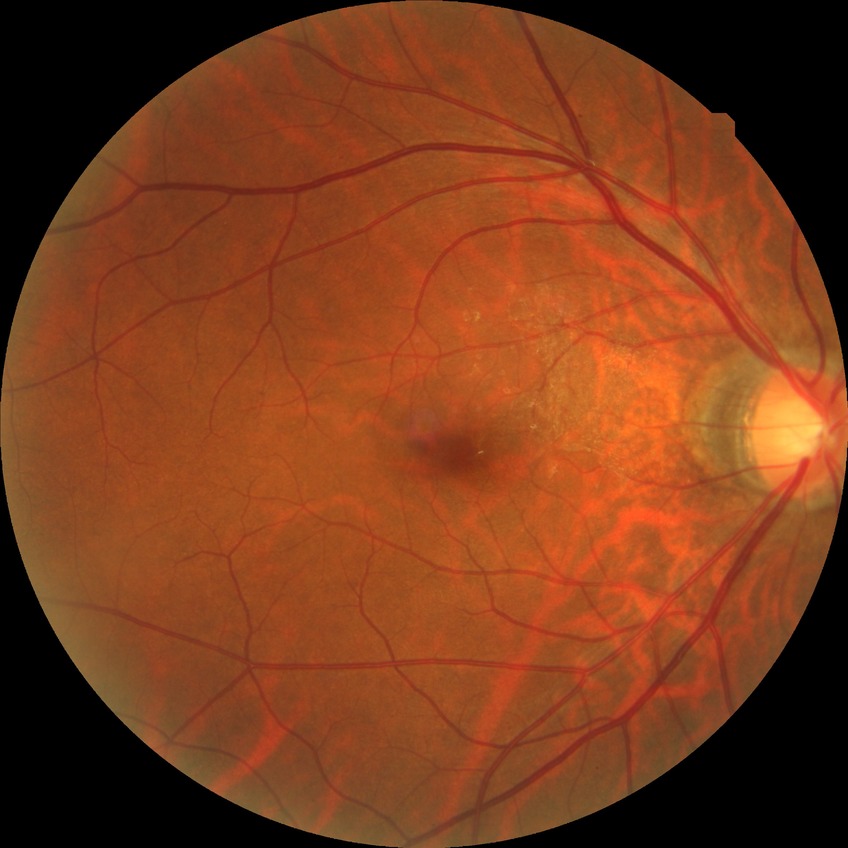
• diabetic retinopathy (DR) — simple diabetic retinopathy (SDR)